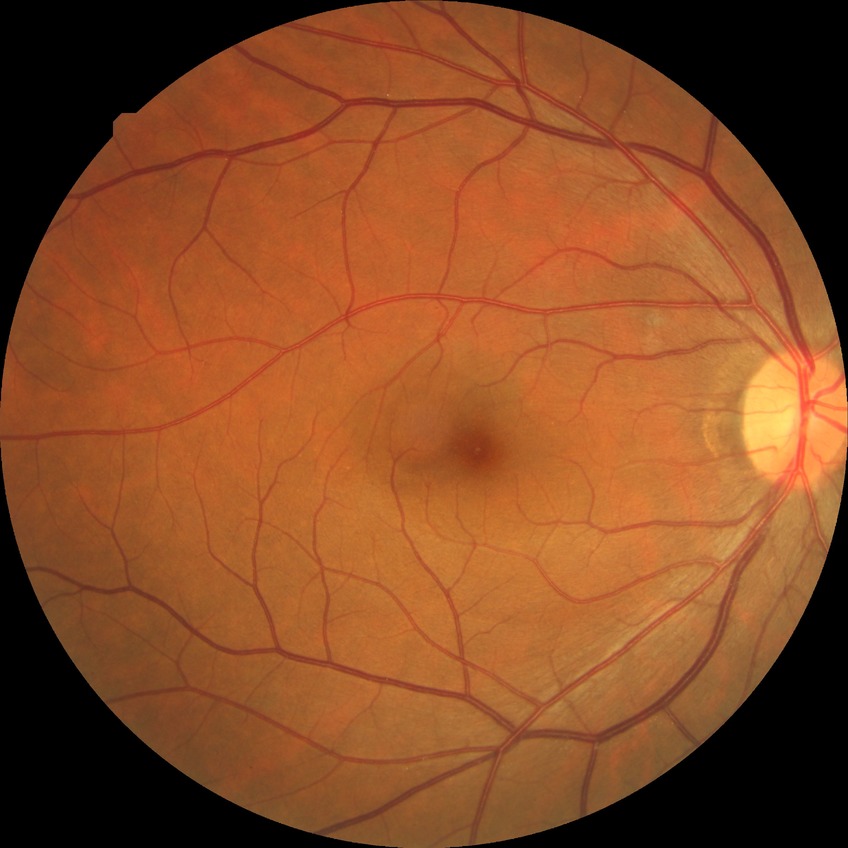
DR class: non-proliferative diabetic retinopathy; diabetic retinopathy severity: simple diabetic retinopathy.